Tabletop color fundus camera image; 50° field of view
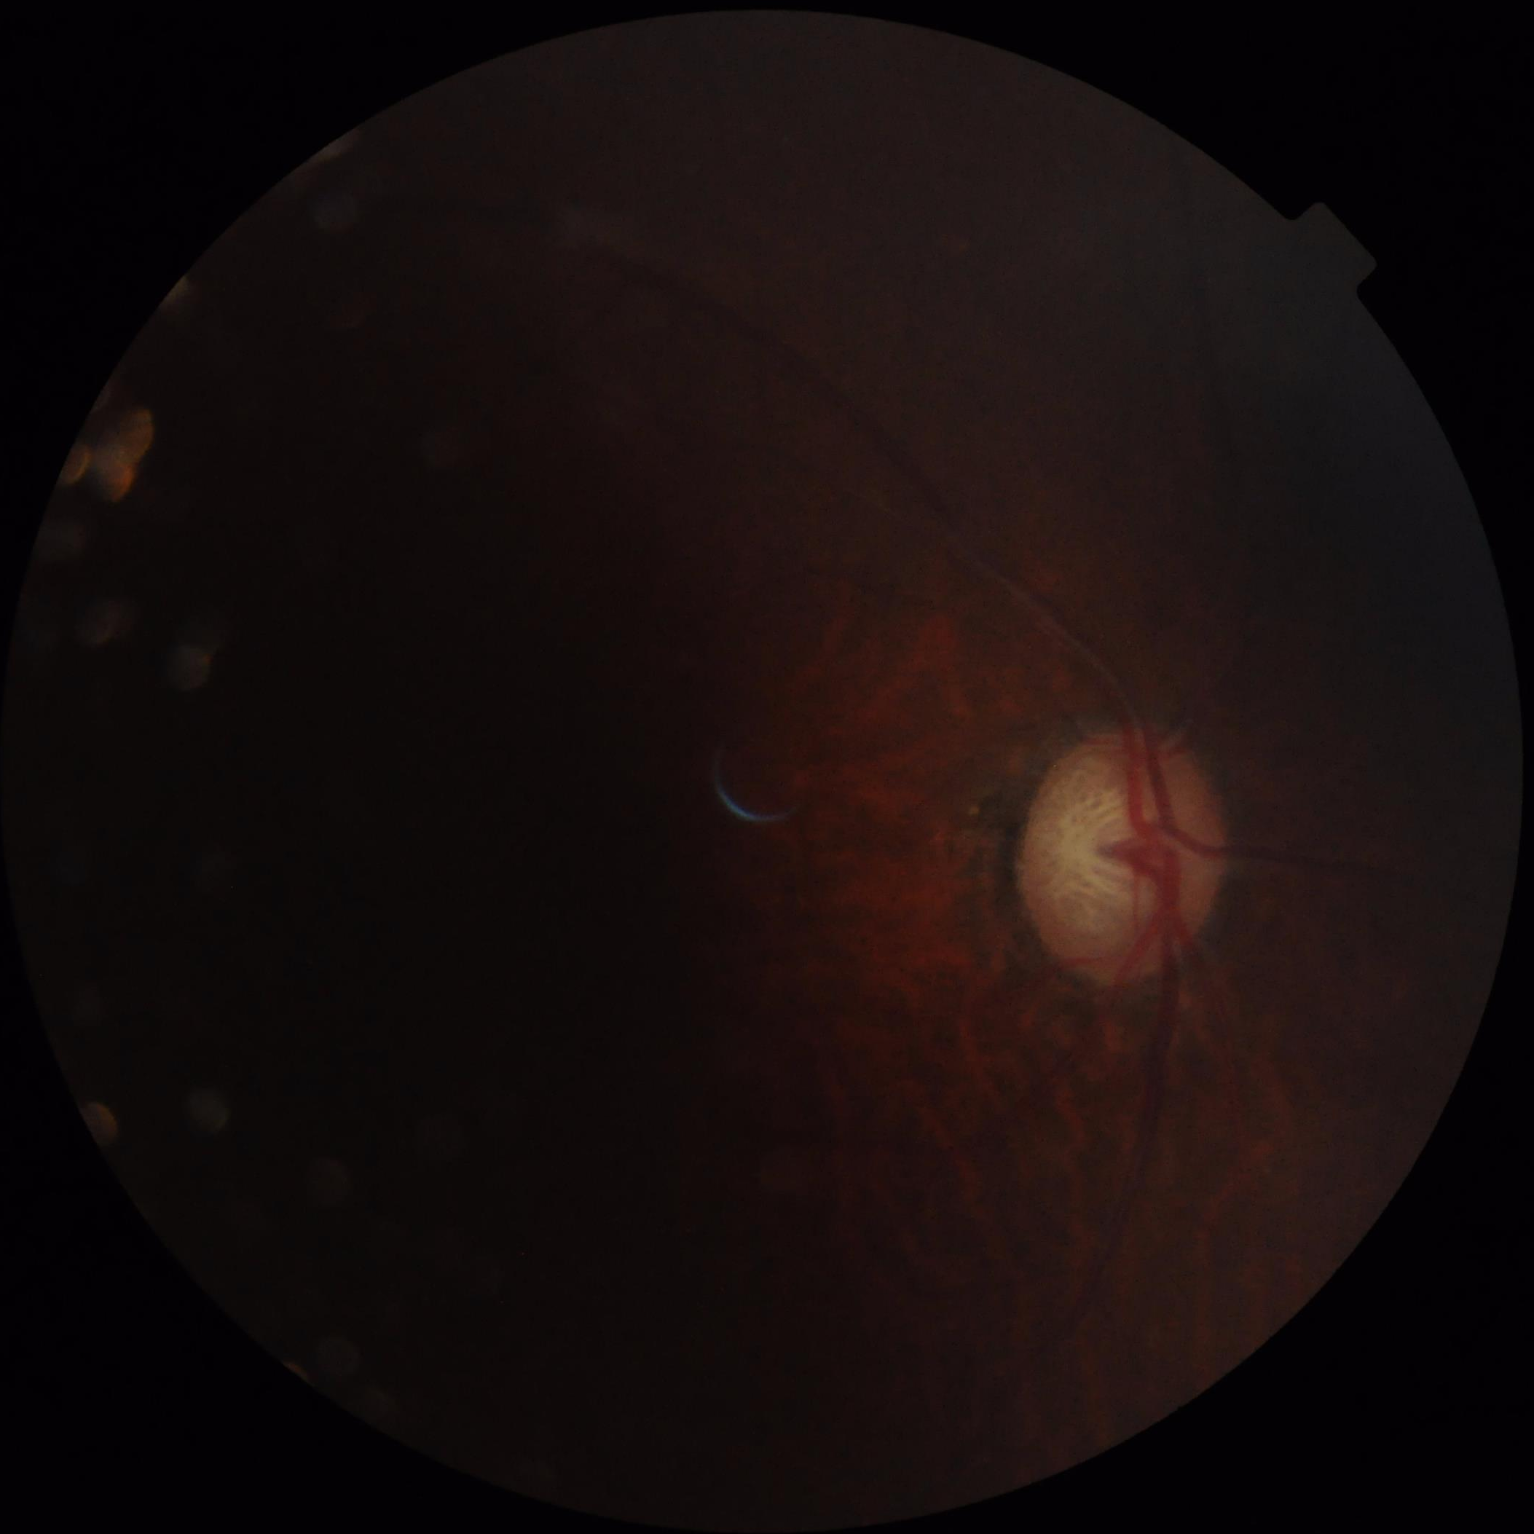

Quality grading: focus: blurry | illumination/color: suboptimal | overall: low | contrast: reduced.